45-degree field of view; color fundus photograph; 2212 x 1659 pixels: 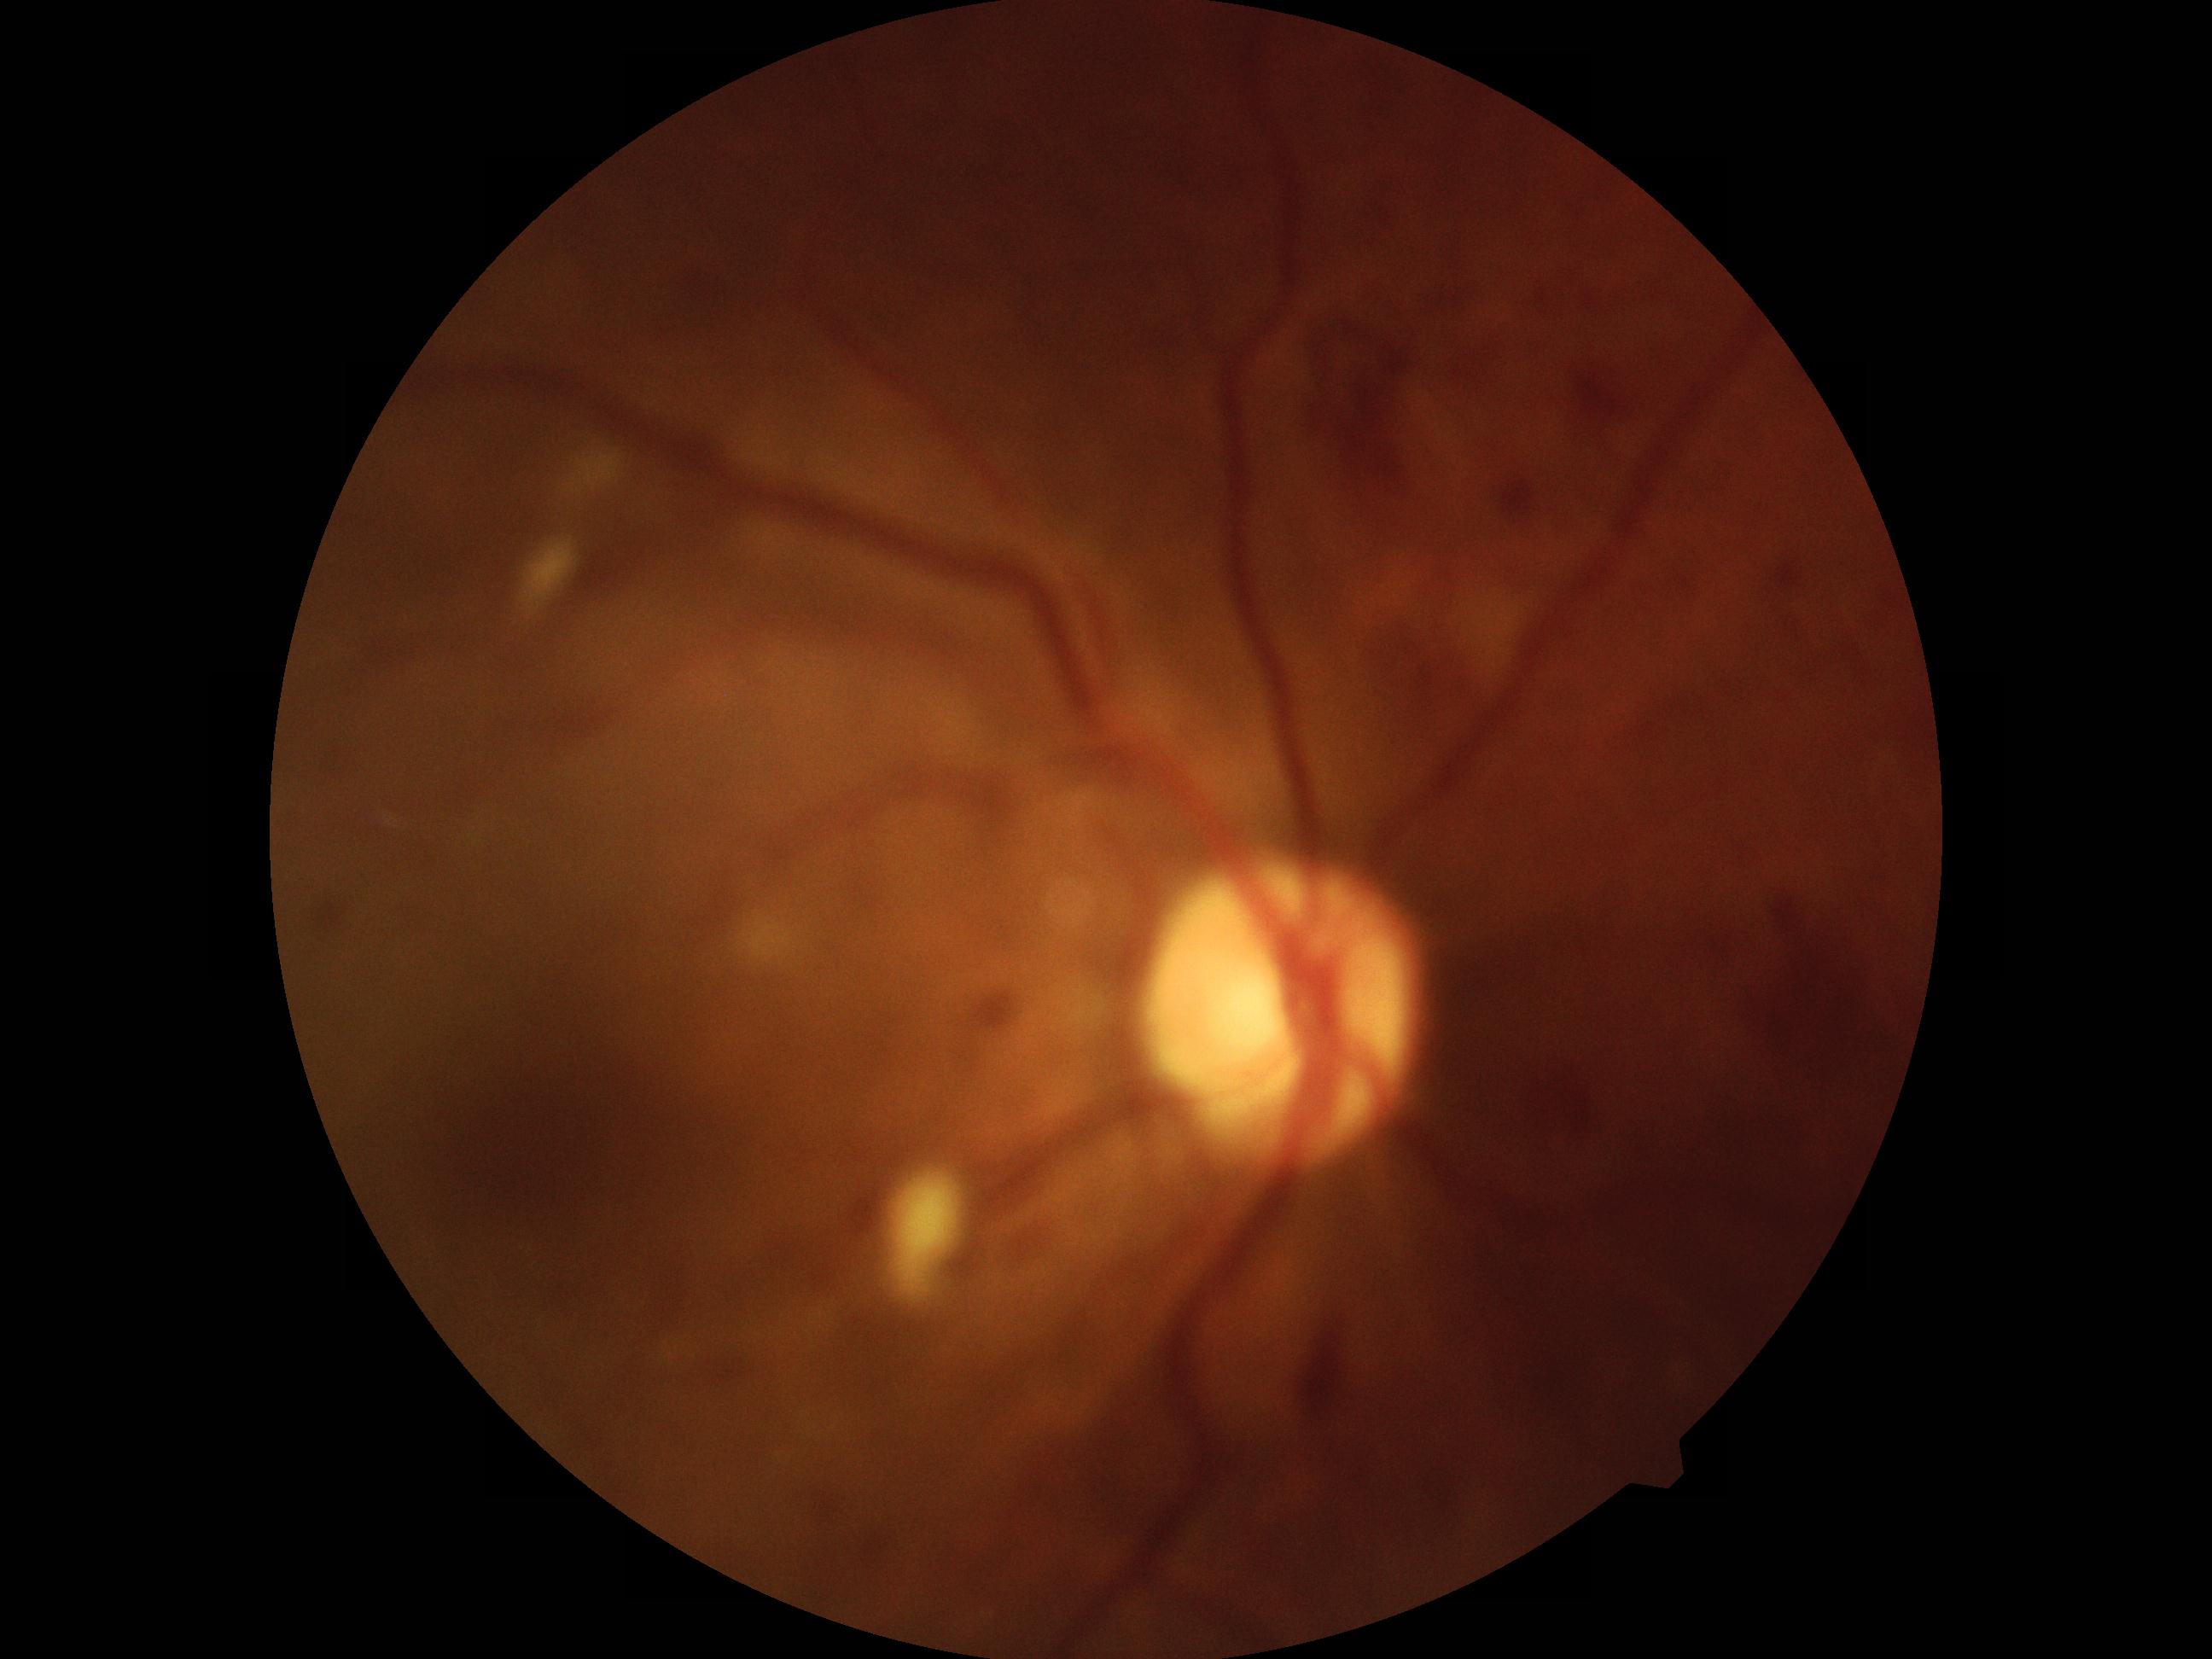

Diabetic retinopathy (DR): grade 3.